Retinal fundus photograph; NIDEK AFC-230 fundus camera; 848 x 848 pixels; 45-degree field of view; nonmydriatic fundus photograph — 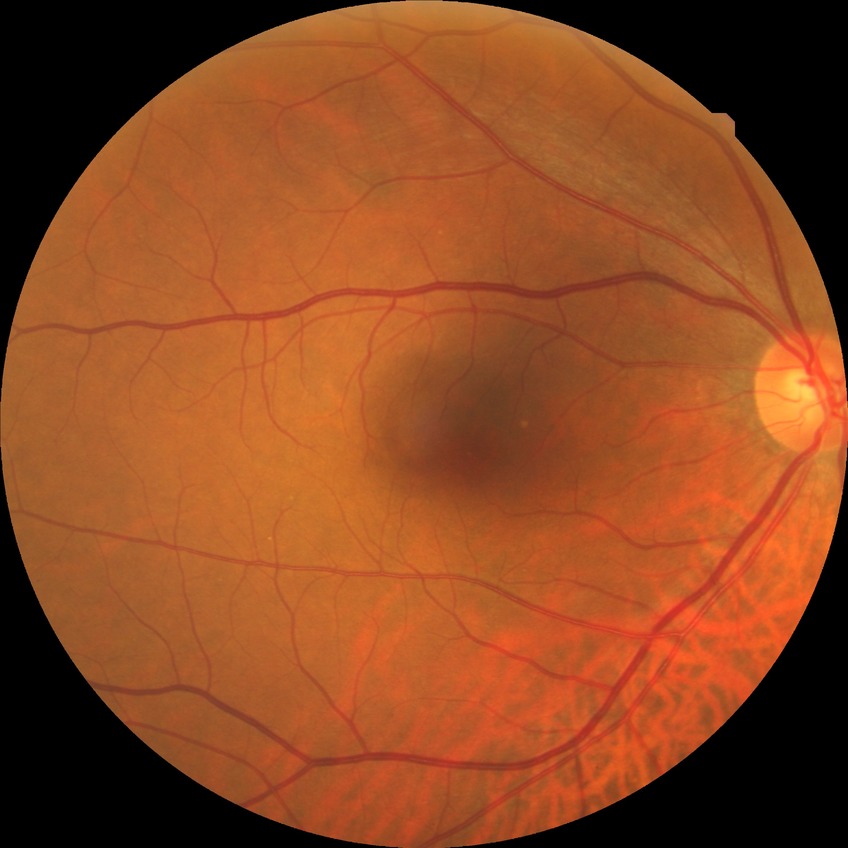 Assessment:
• diabetic retinopathy (DR) — no diabetic retinopathy (NDR)